Nonmydriatic · 848x848px · NIDEK AFC-230
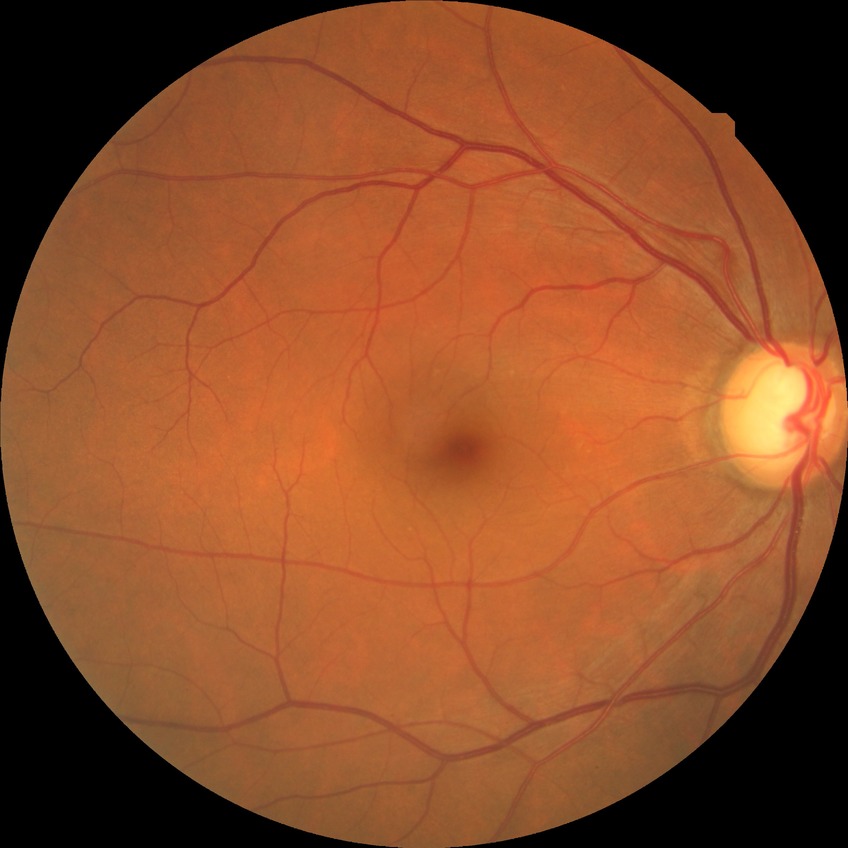

Diabetic retinopathy (DR) is NDR (no diabetic retinopathy).